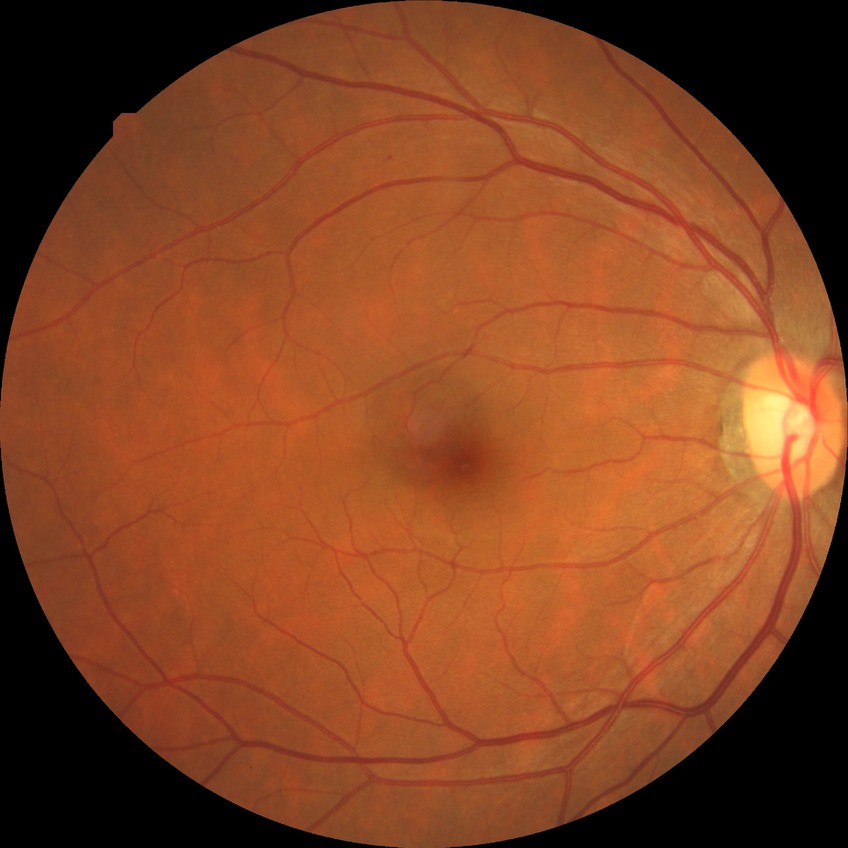 Diabetic retinopathy severity: simple diabetic retinopathy.